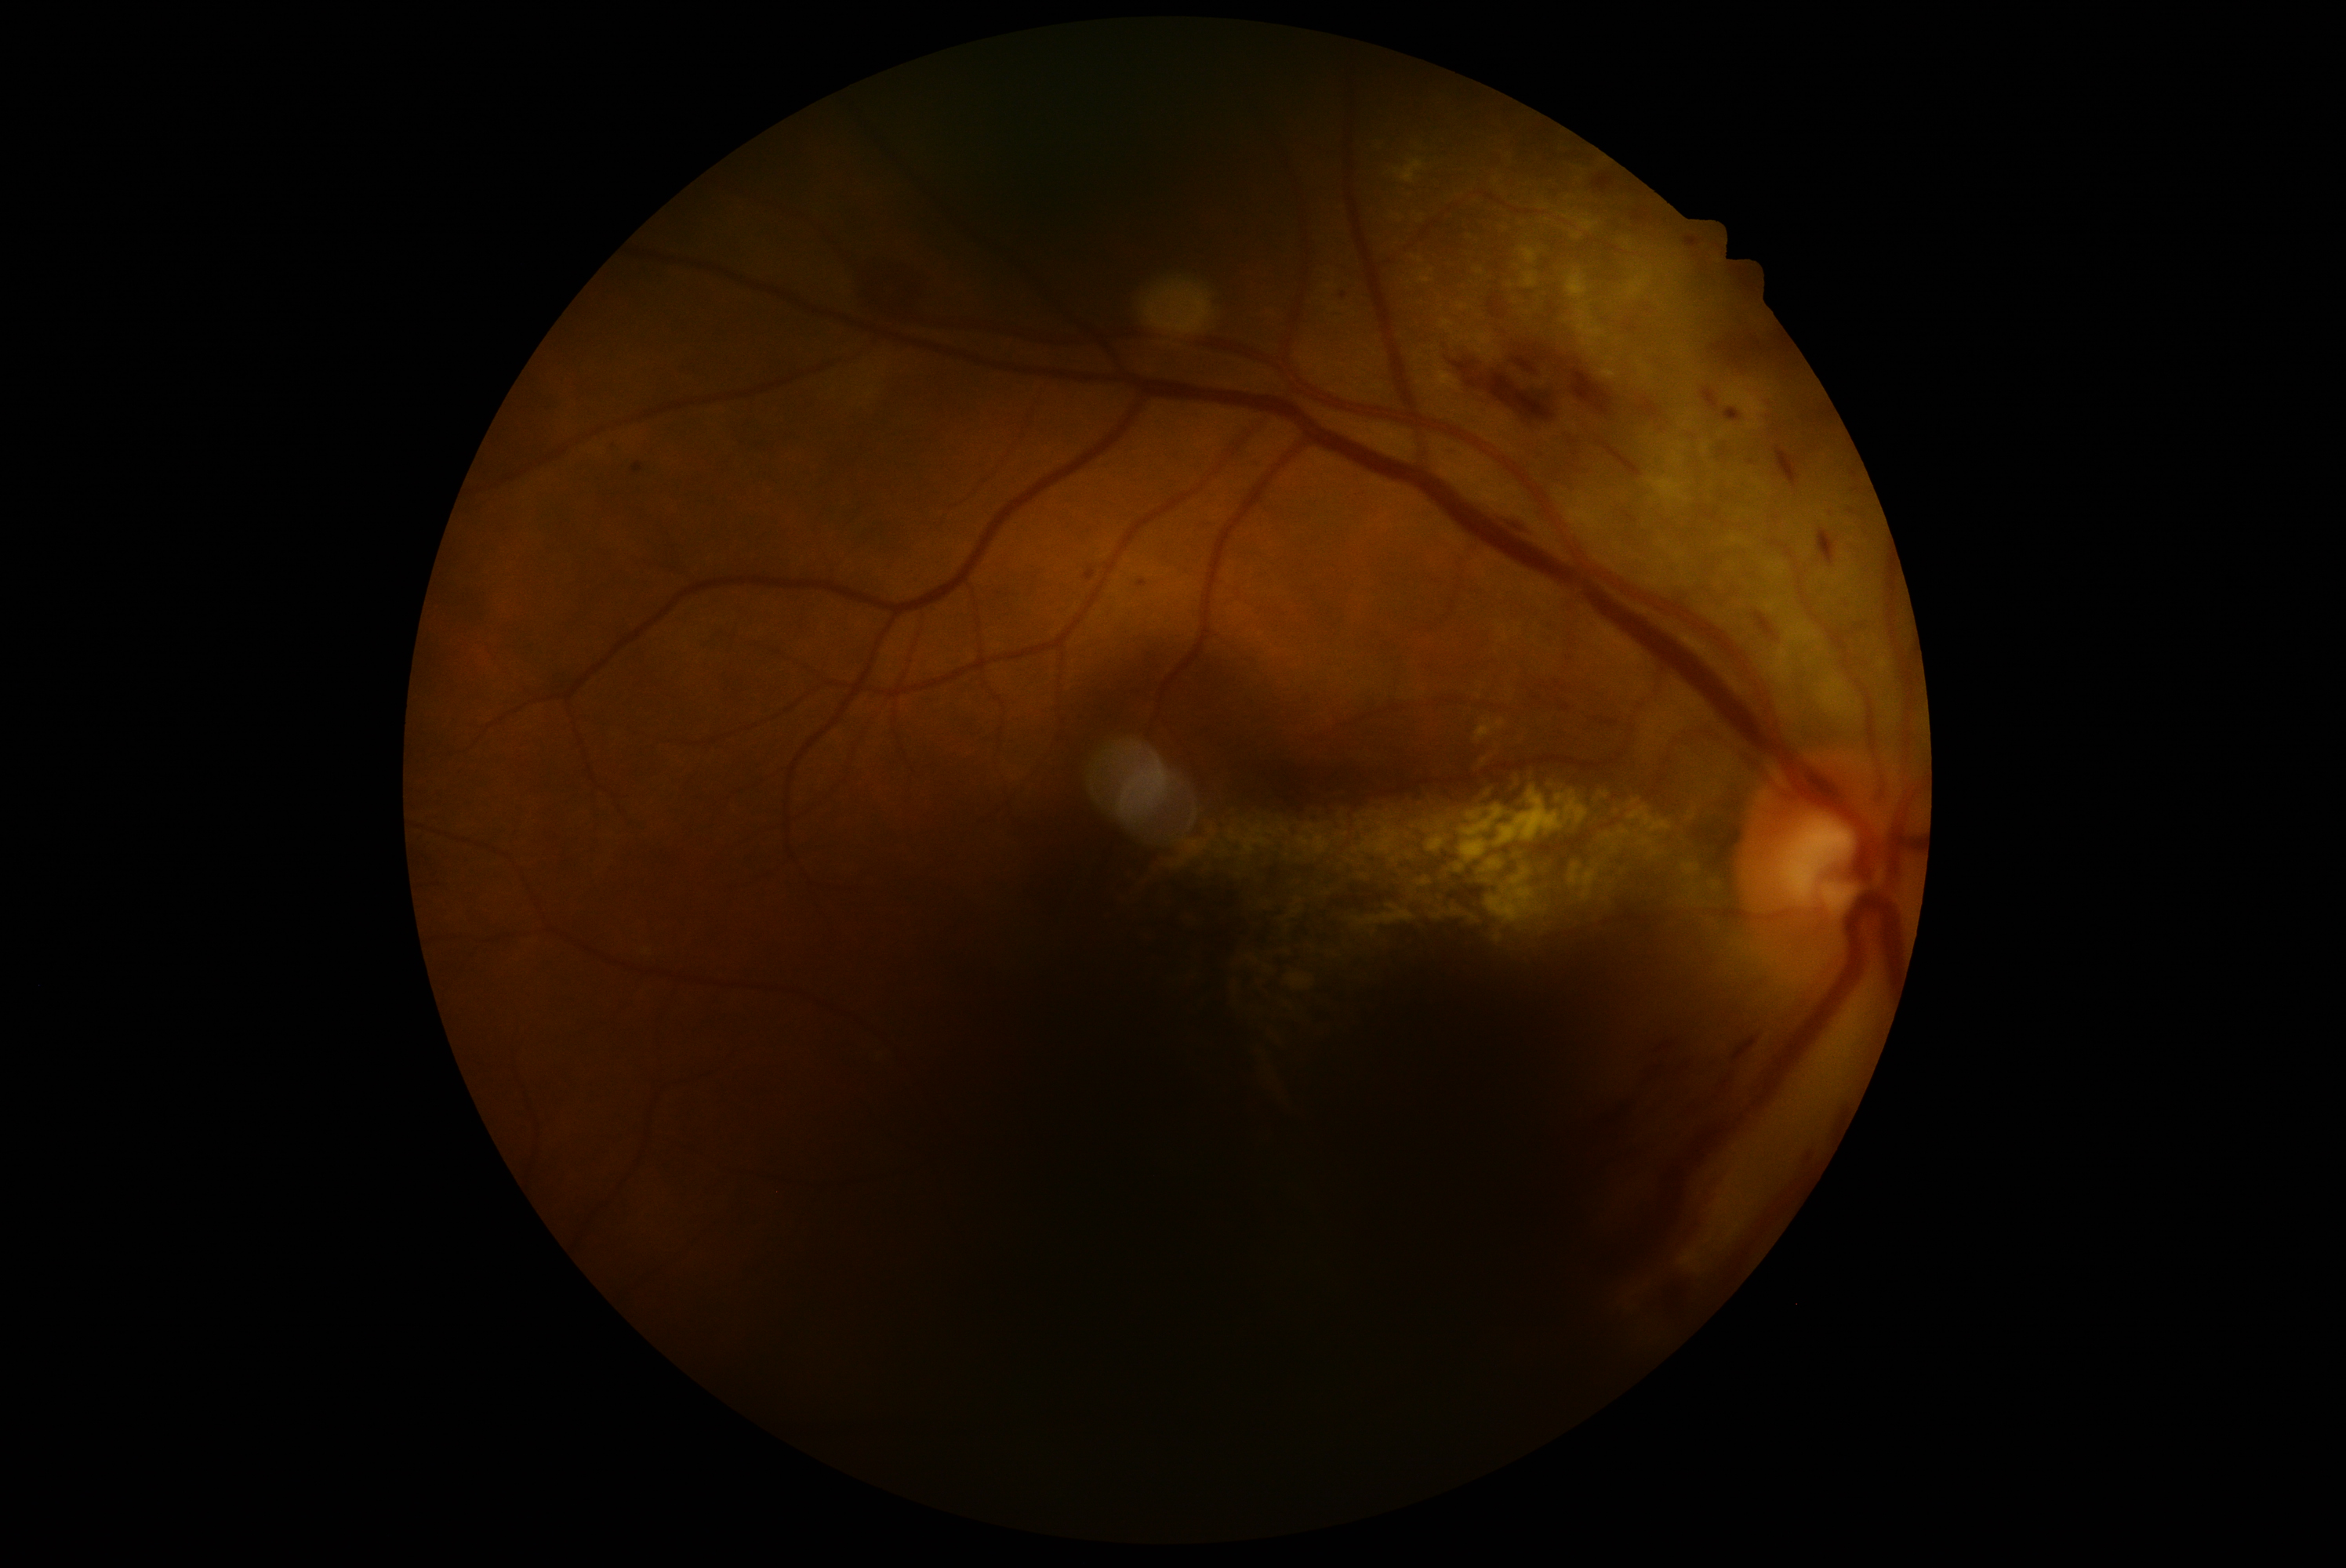 Diabetic retinopathy: grade 2 — more than just microaneurysms but less than severe NPDR.
The retinopathy is classified as non-proliferative diabetic retinopathy.